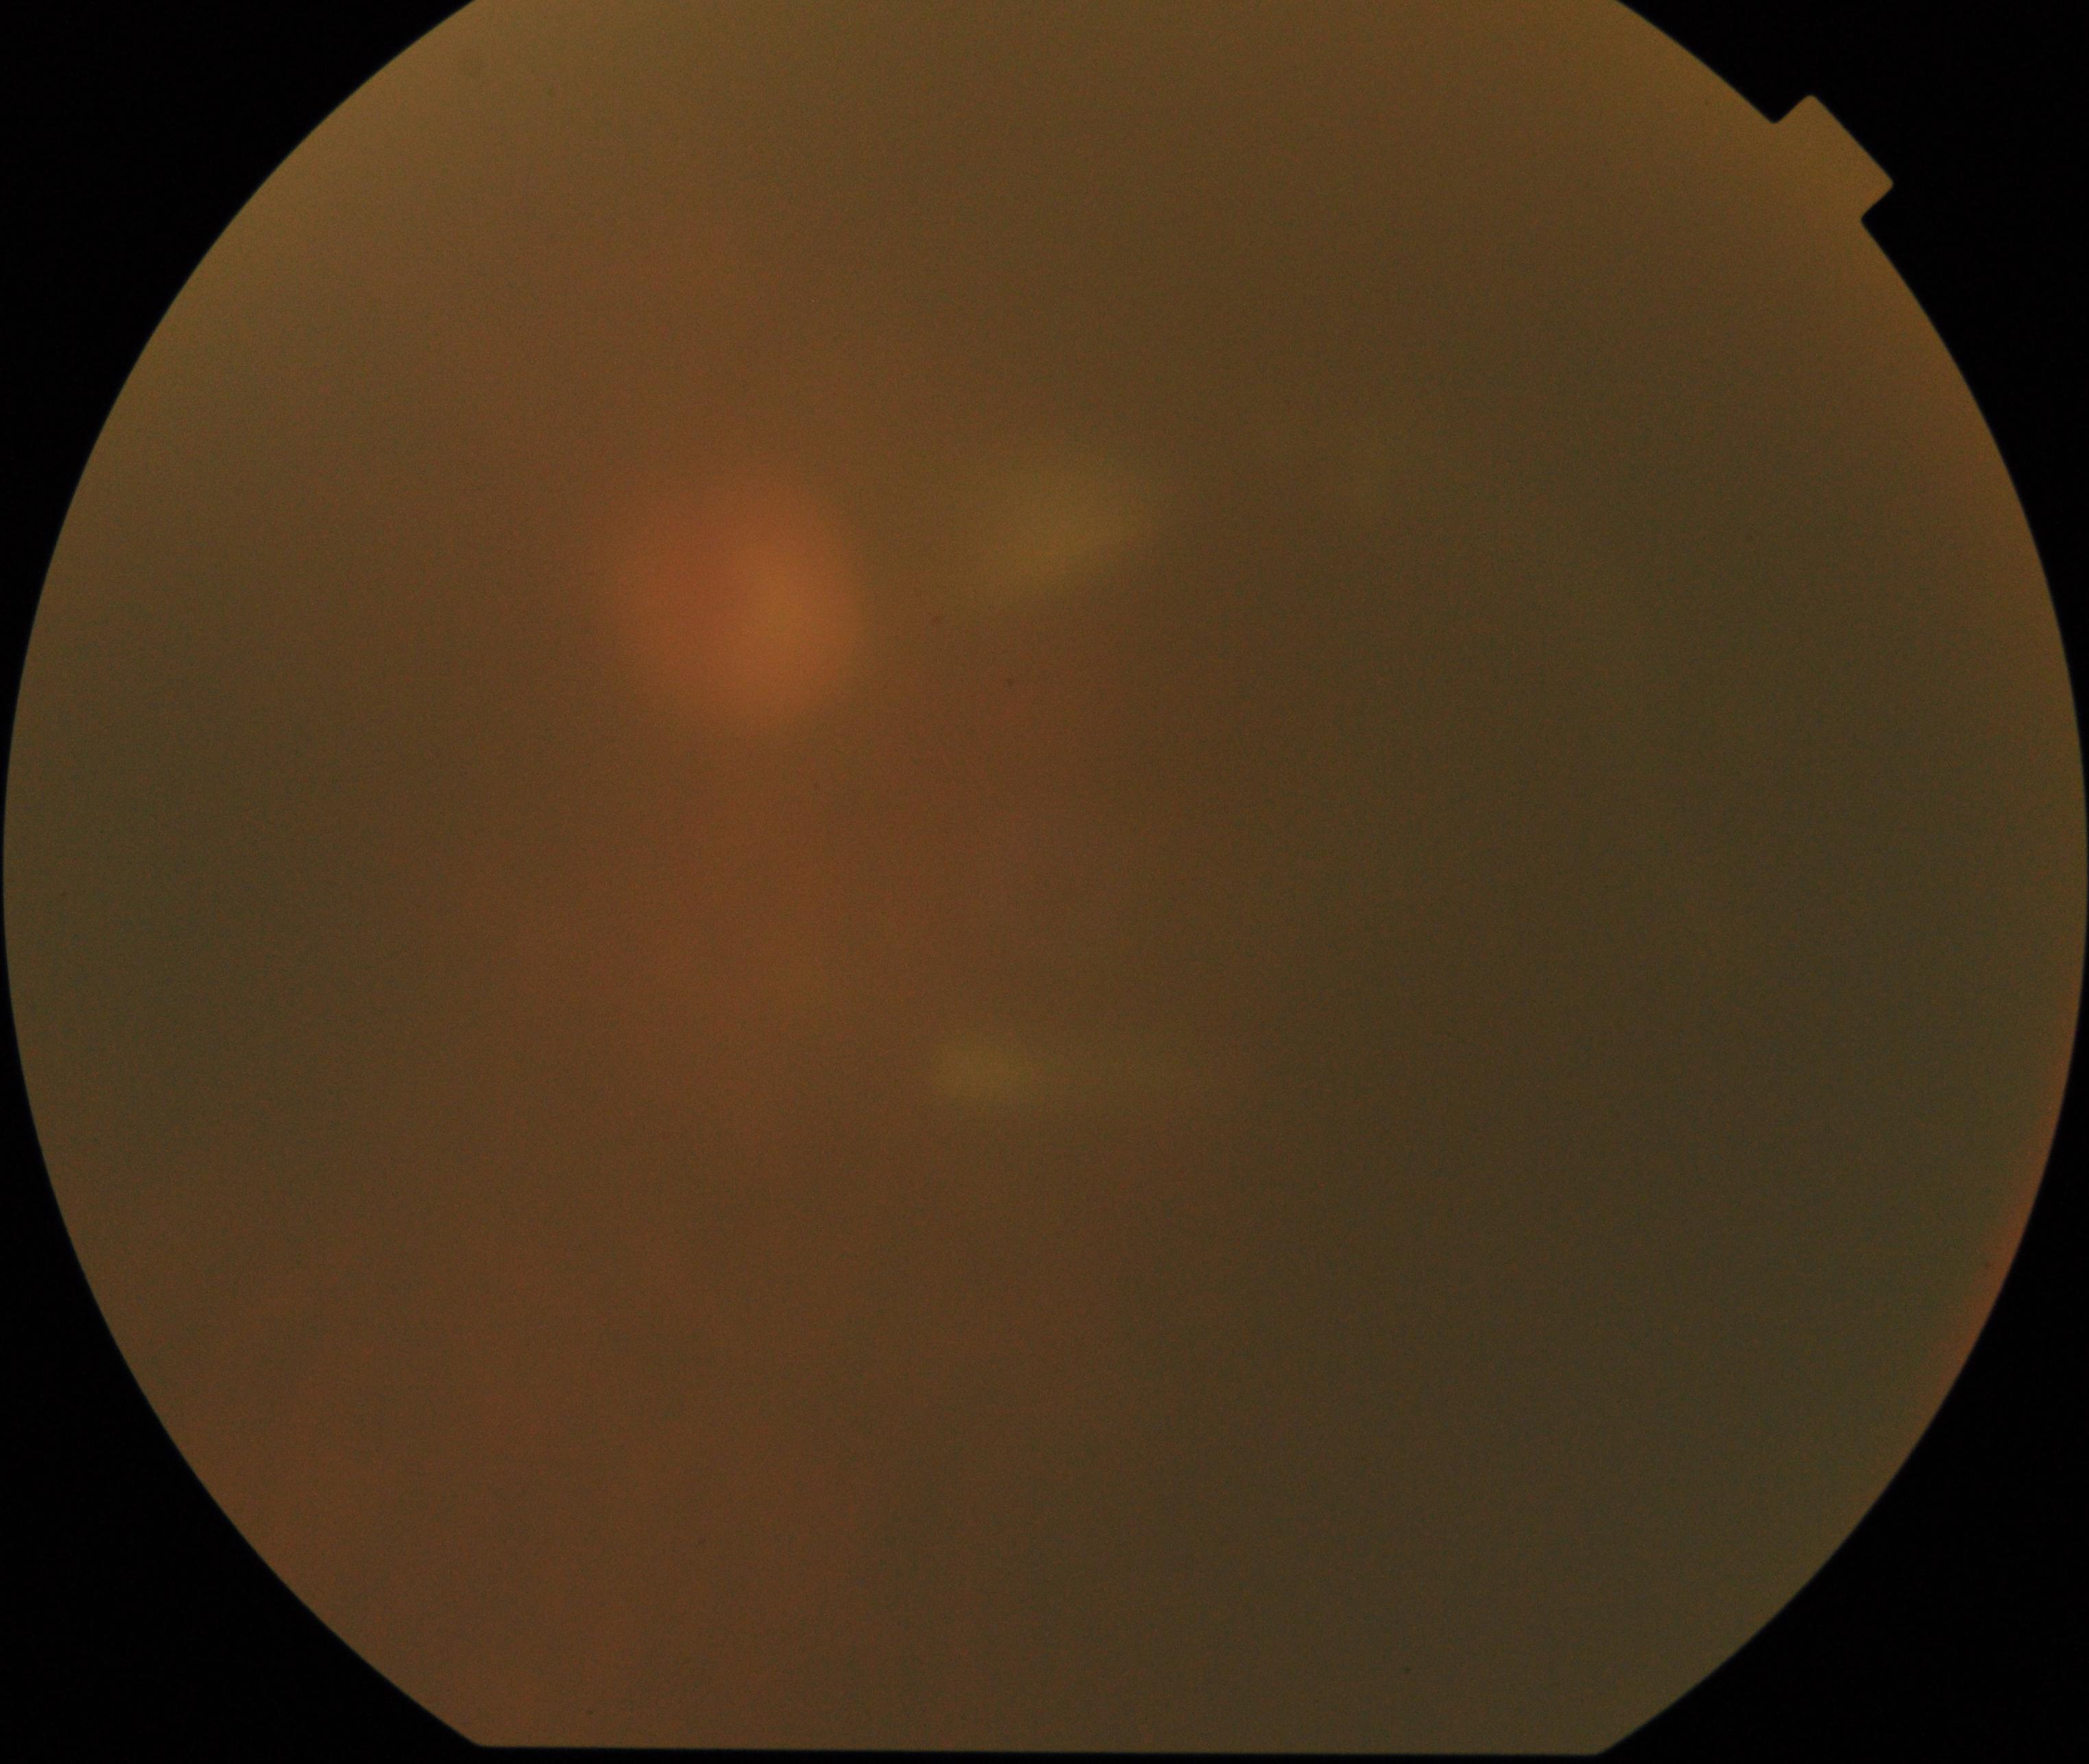

Image is blurred; retinal landmarks are largely obscured. No evidence of proliferative diabetic retinopathy.